Fundus photo; 848x848.
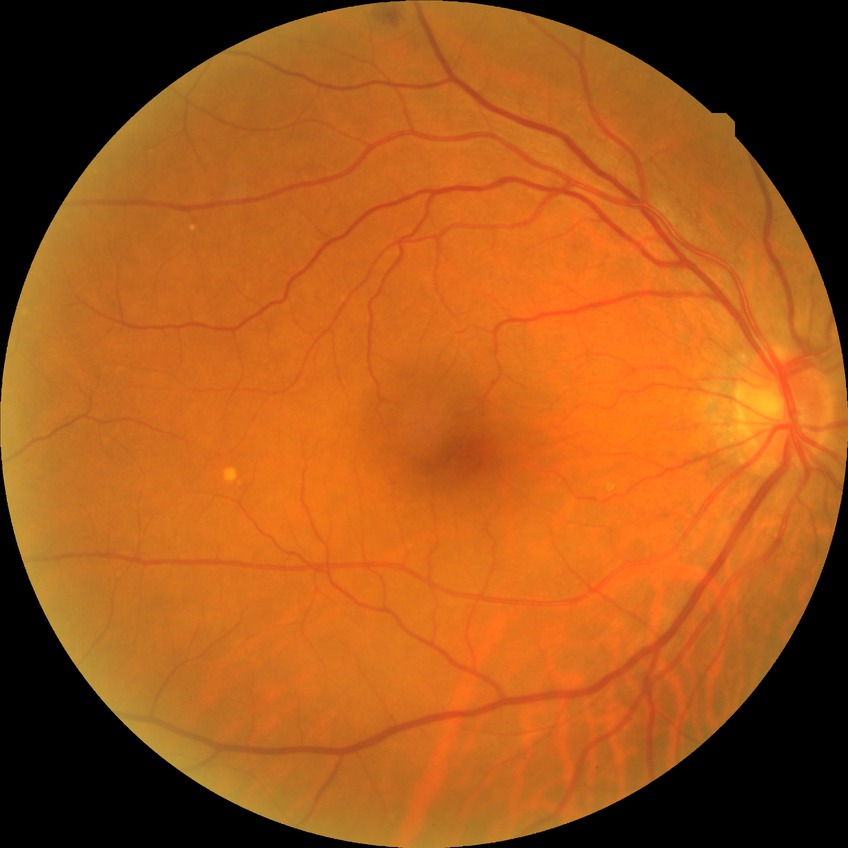
  davis_grade: no diabetic retinopathy (NDR)